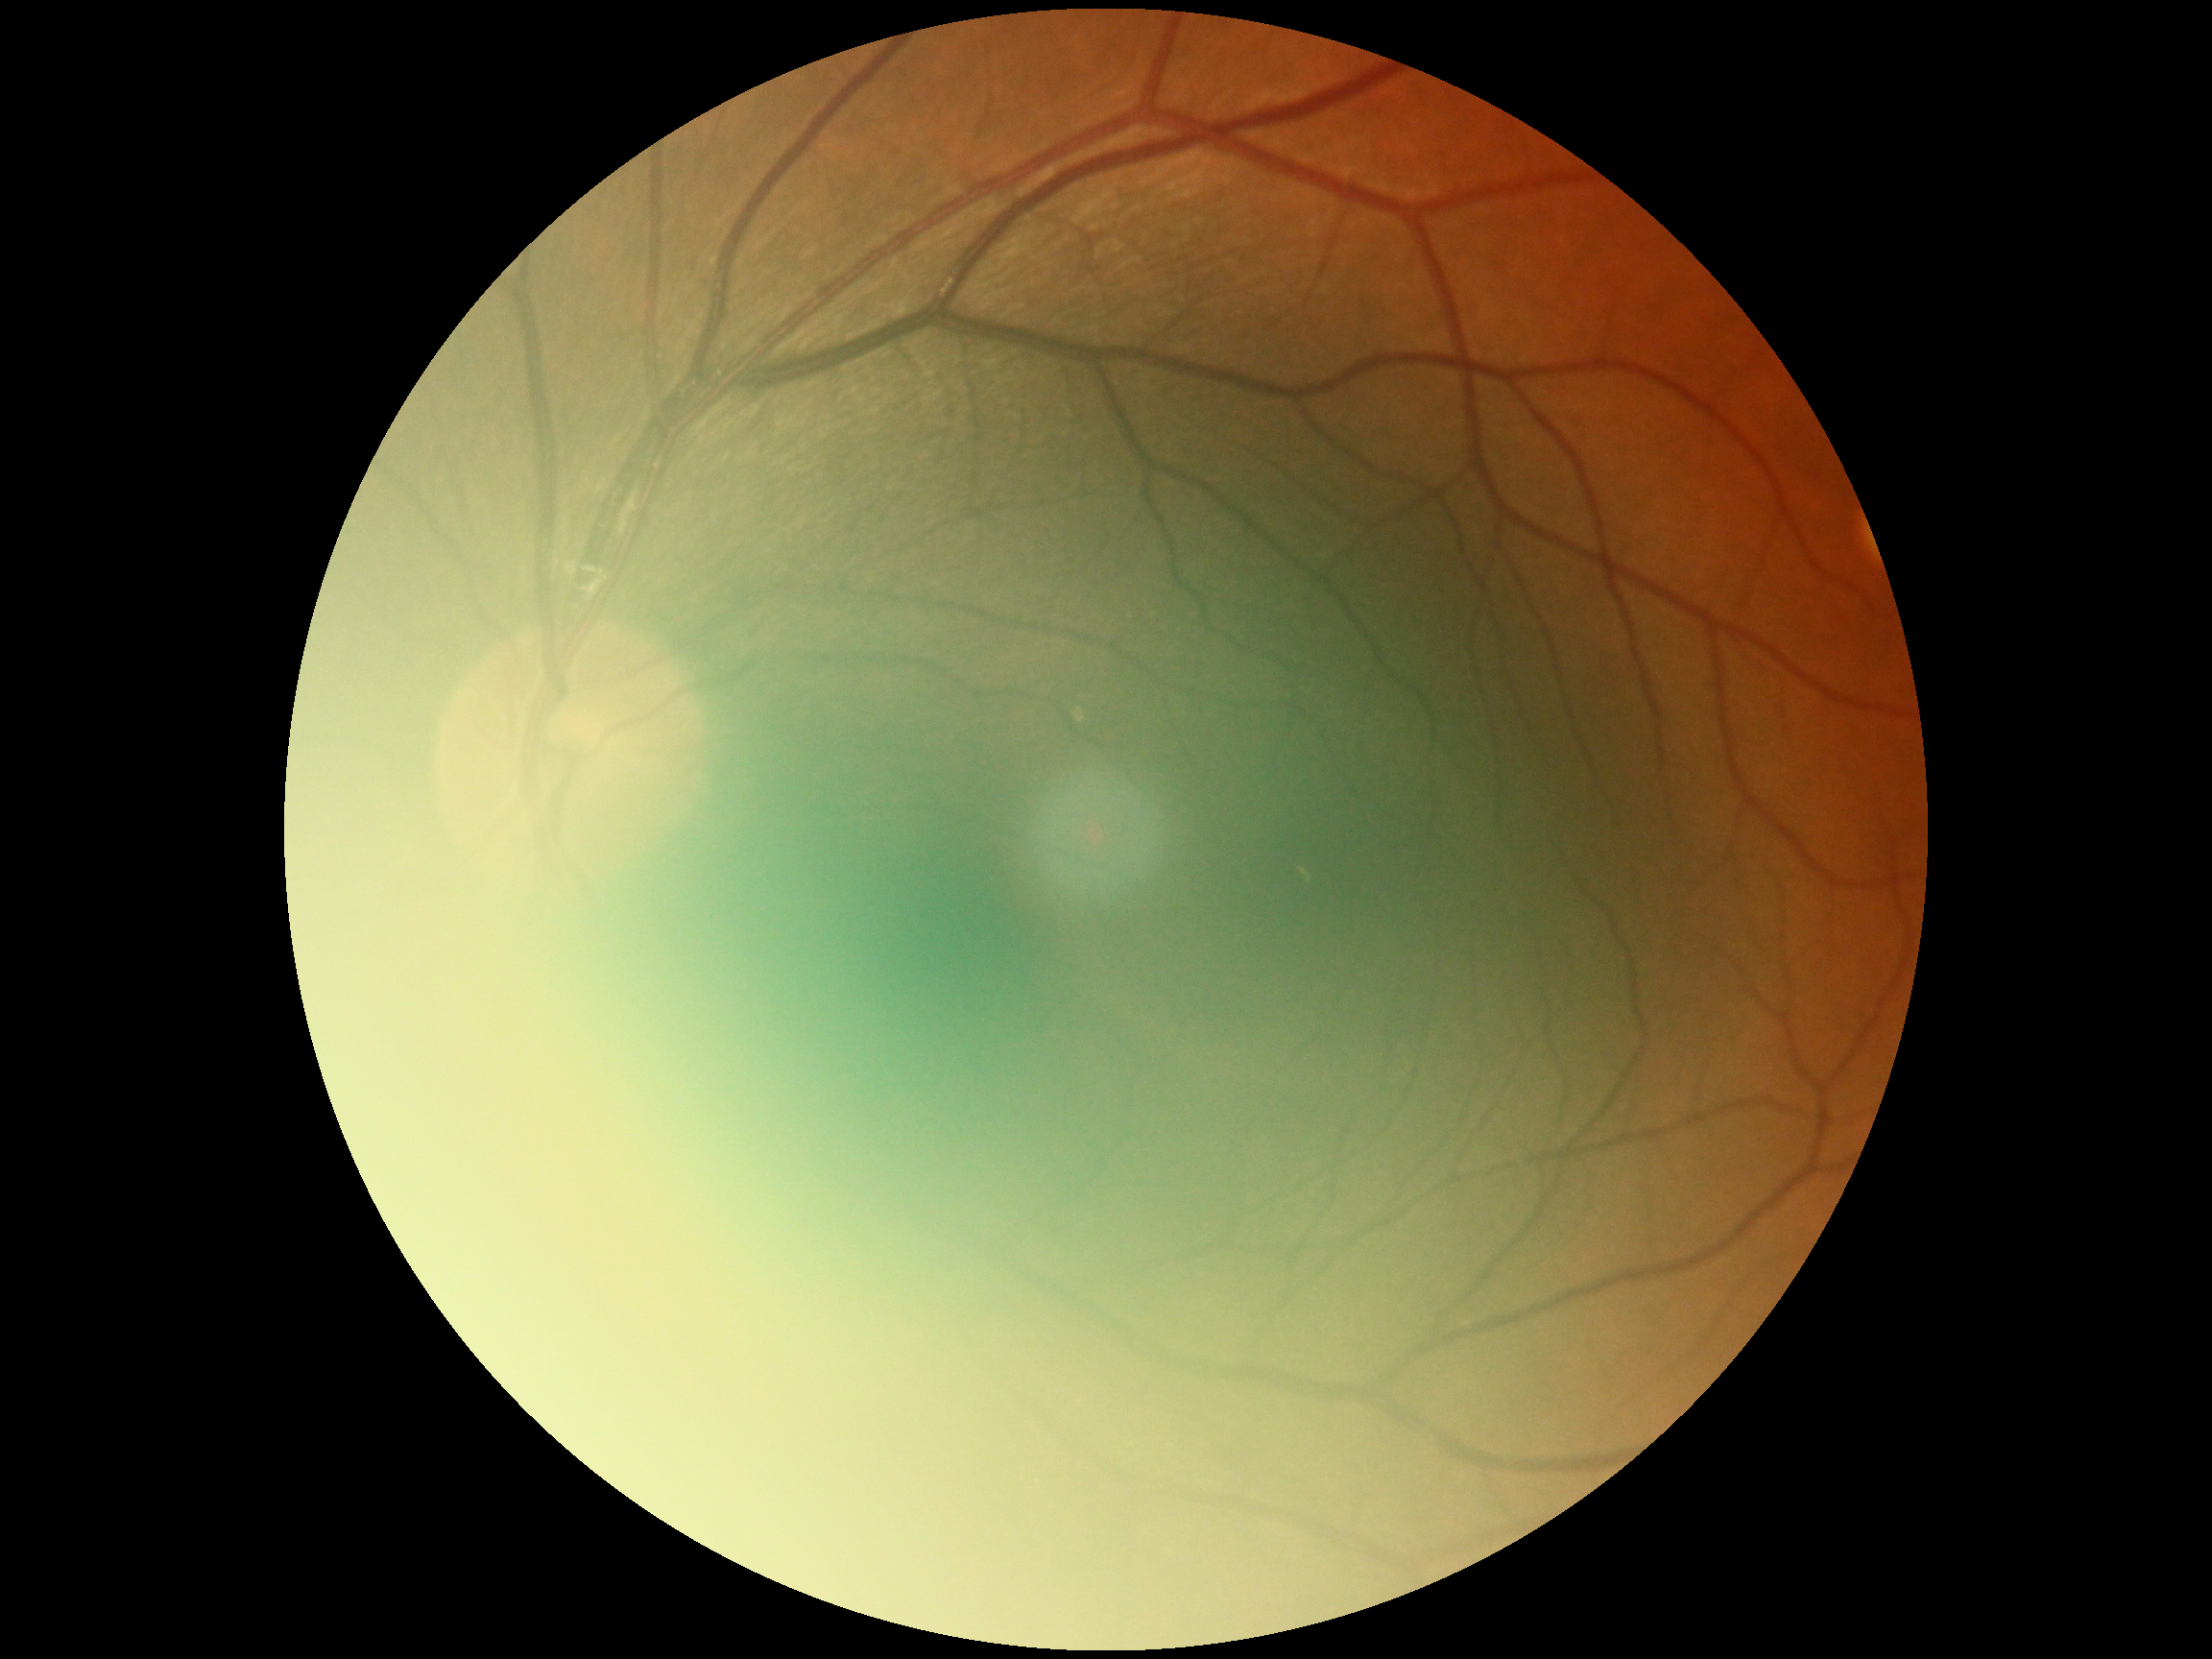 Diabetic retinopathy (DR): no apparent diabetic retinopathy (grade 0).